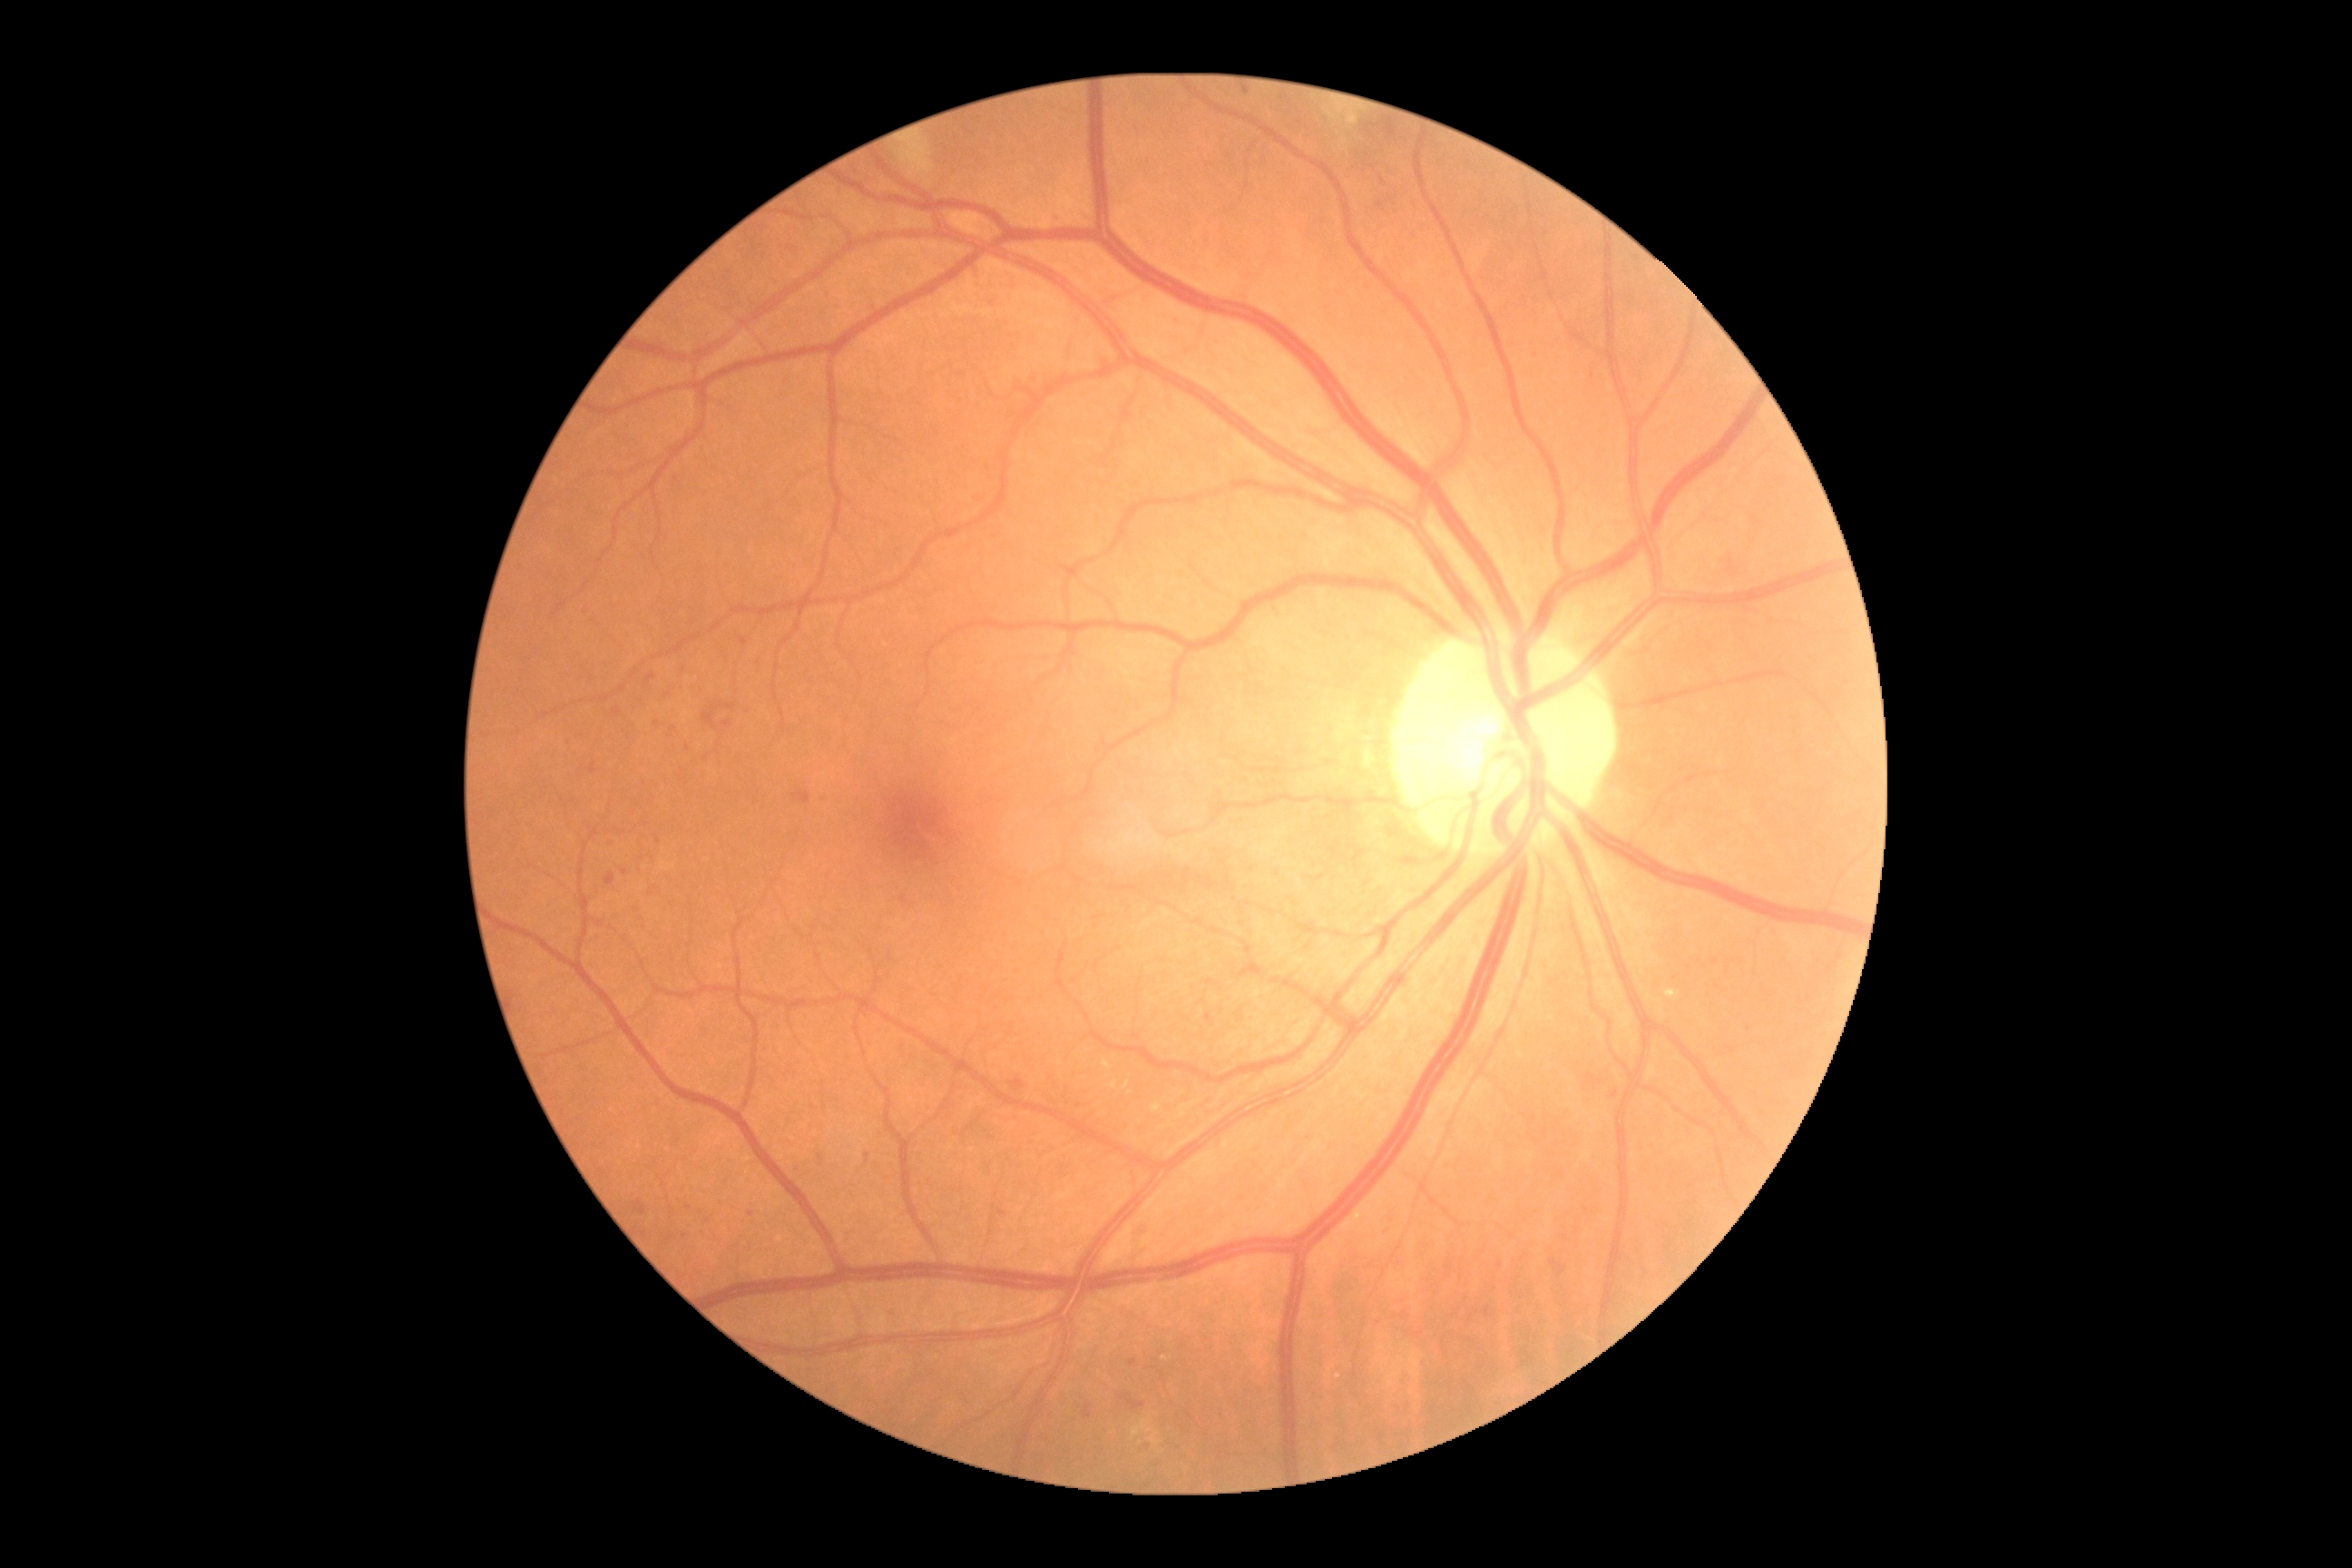 diabetic retinopathy (DR) = 2/4.